Diabetic retinopathy graded by the modified Davis classification.
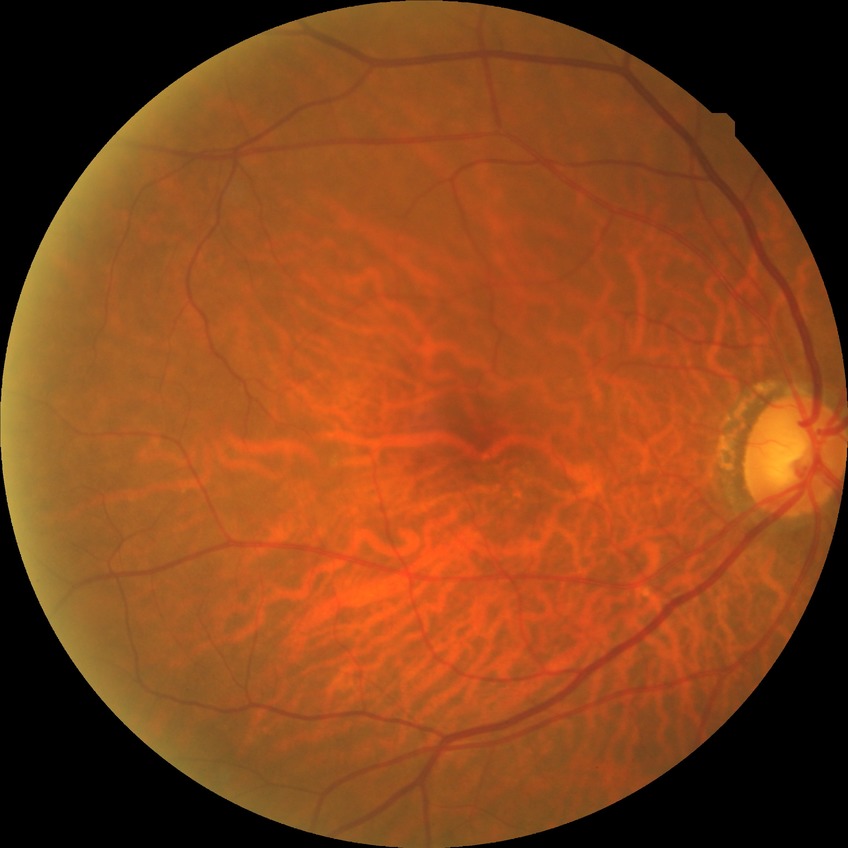 Diabetic retinopathy stage is no diabetic retinopathy.